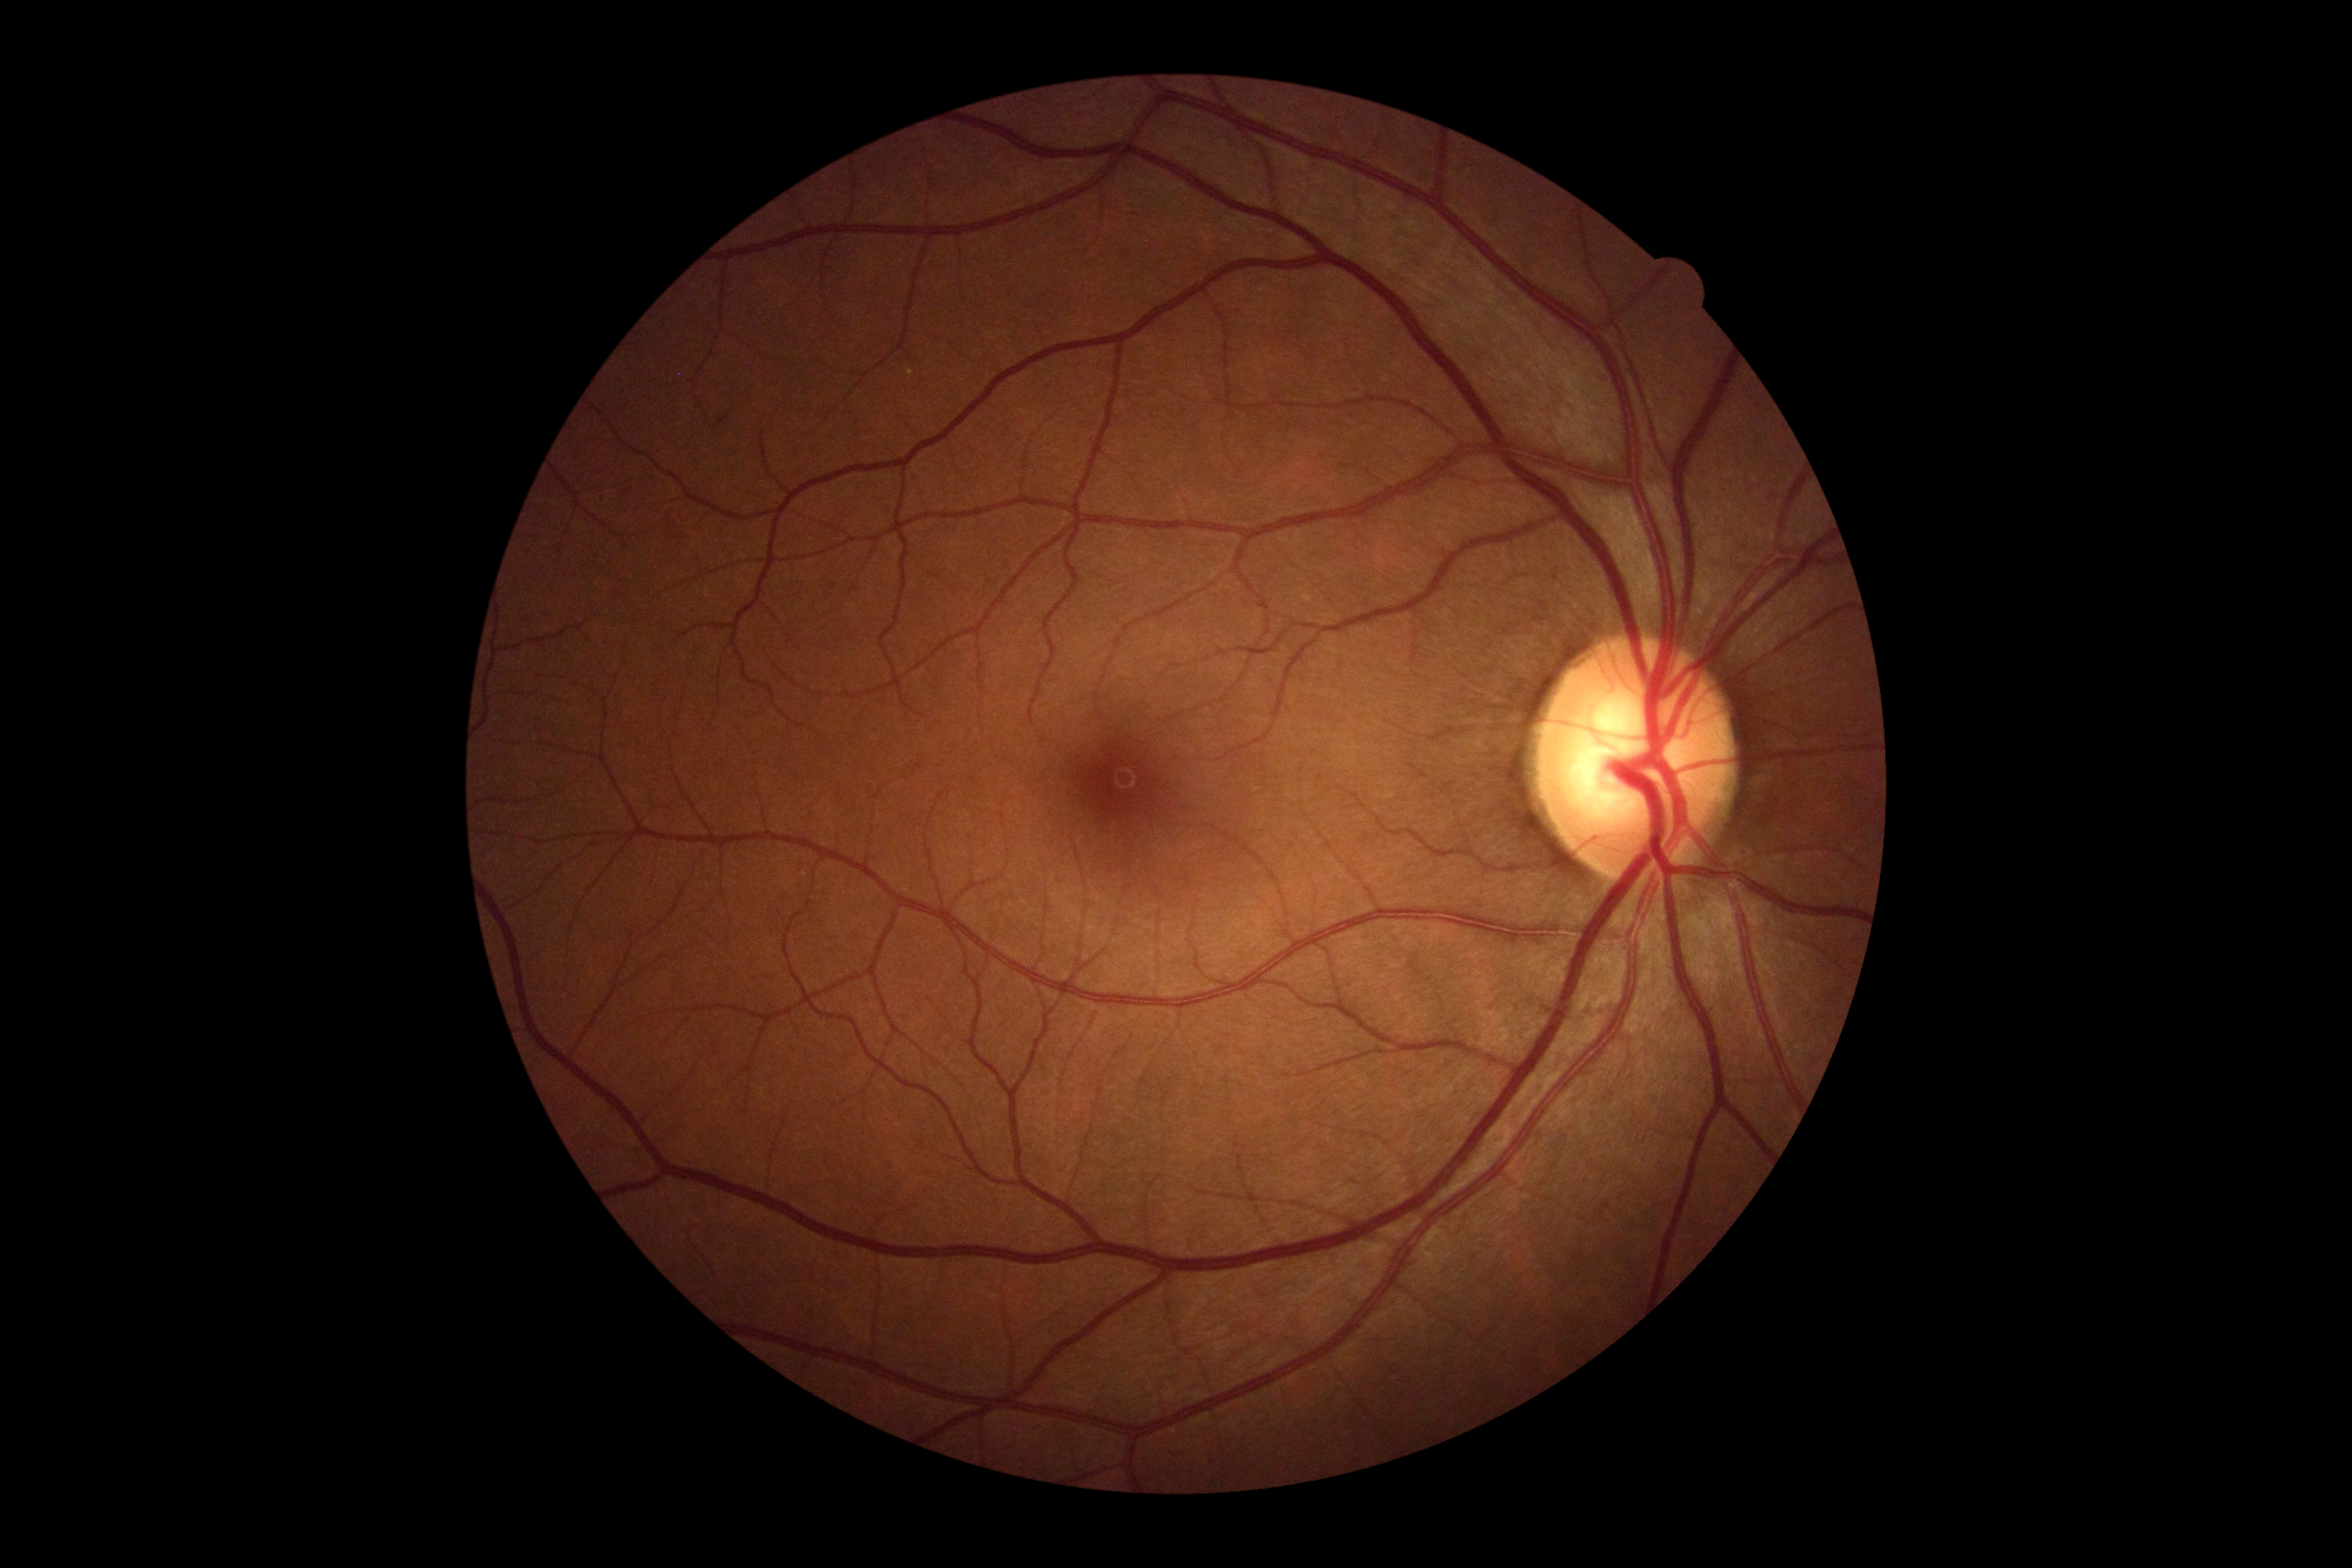

DR grade=0, DR impression=no signs of DR.